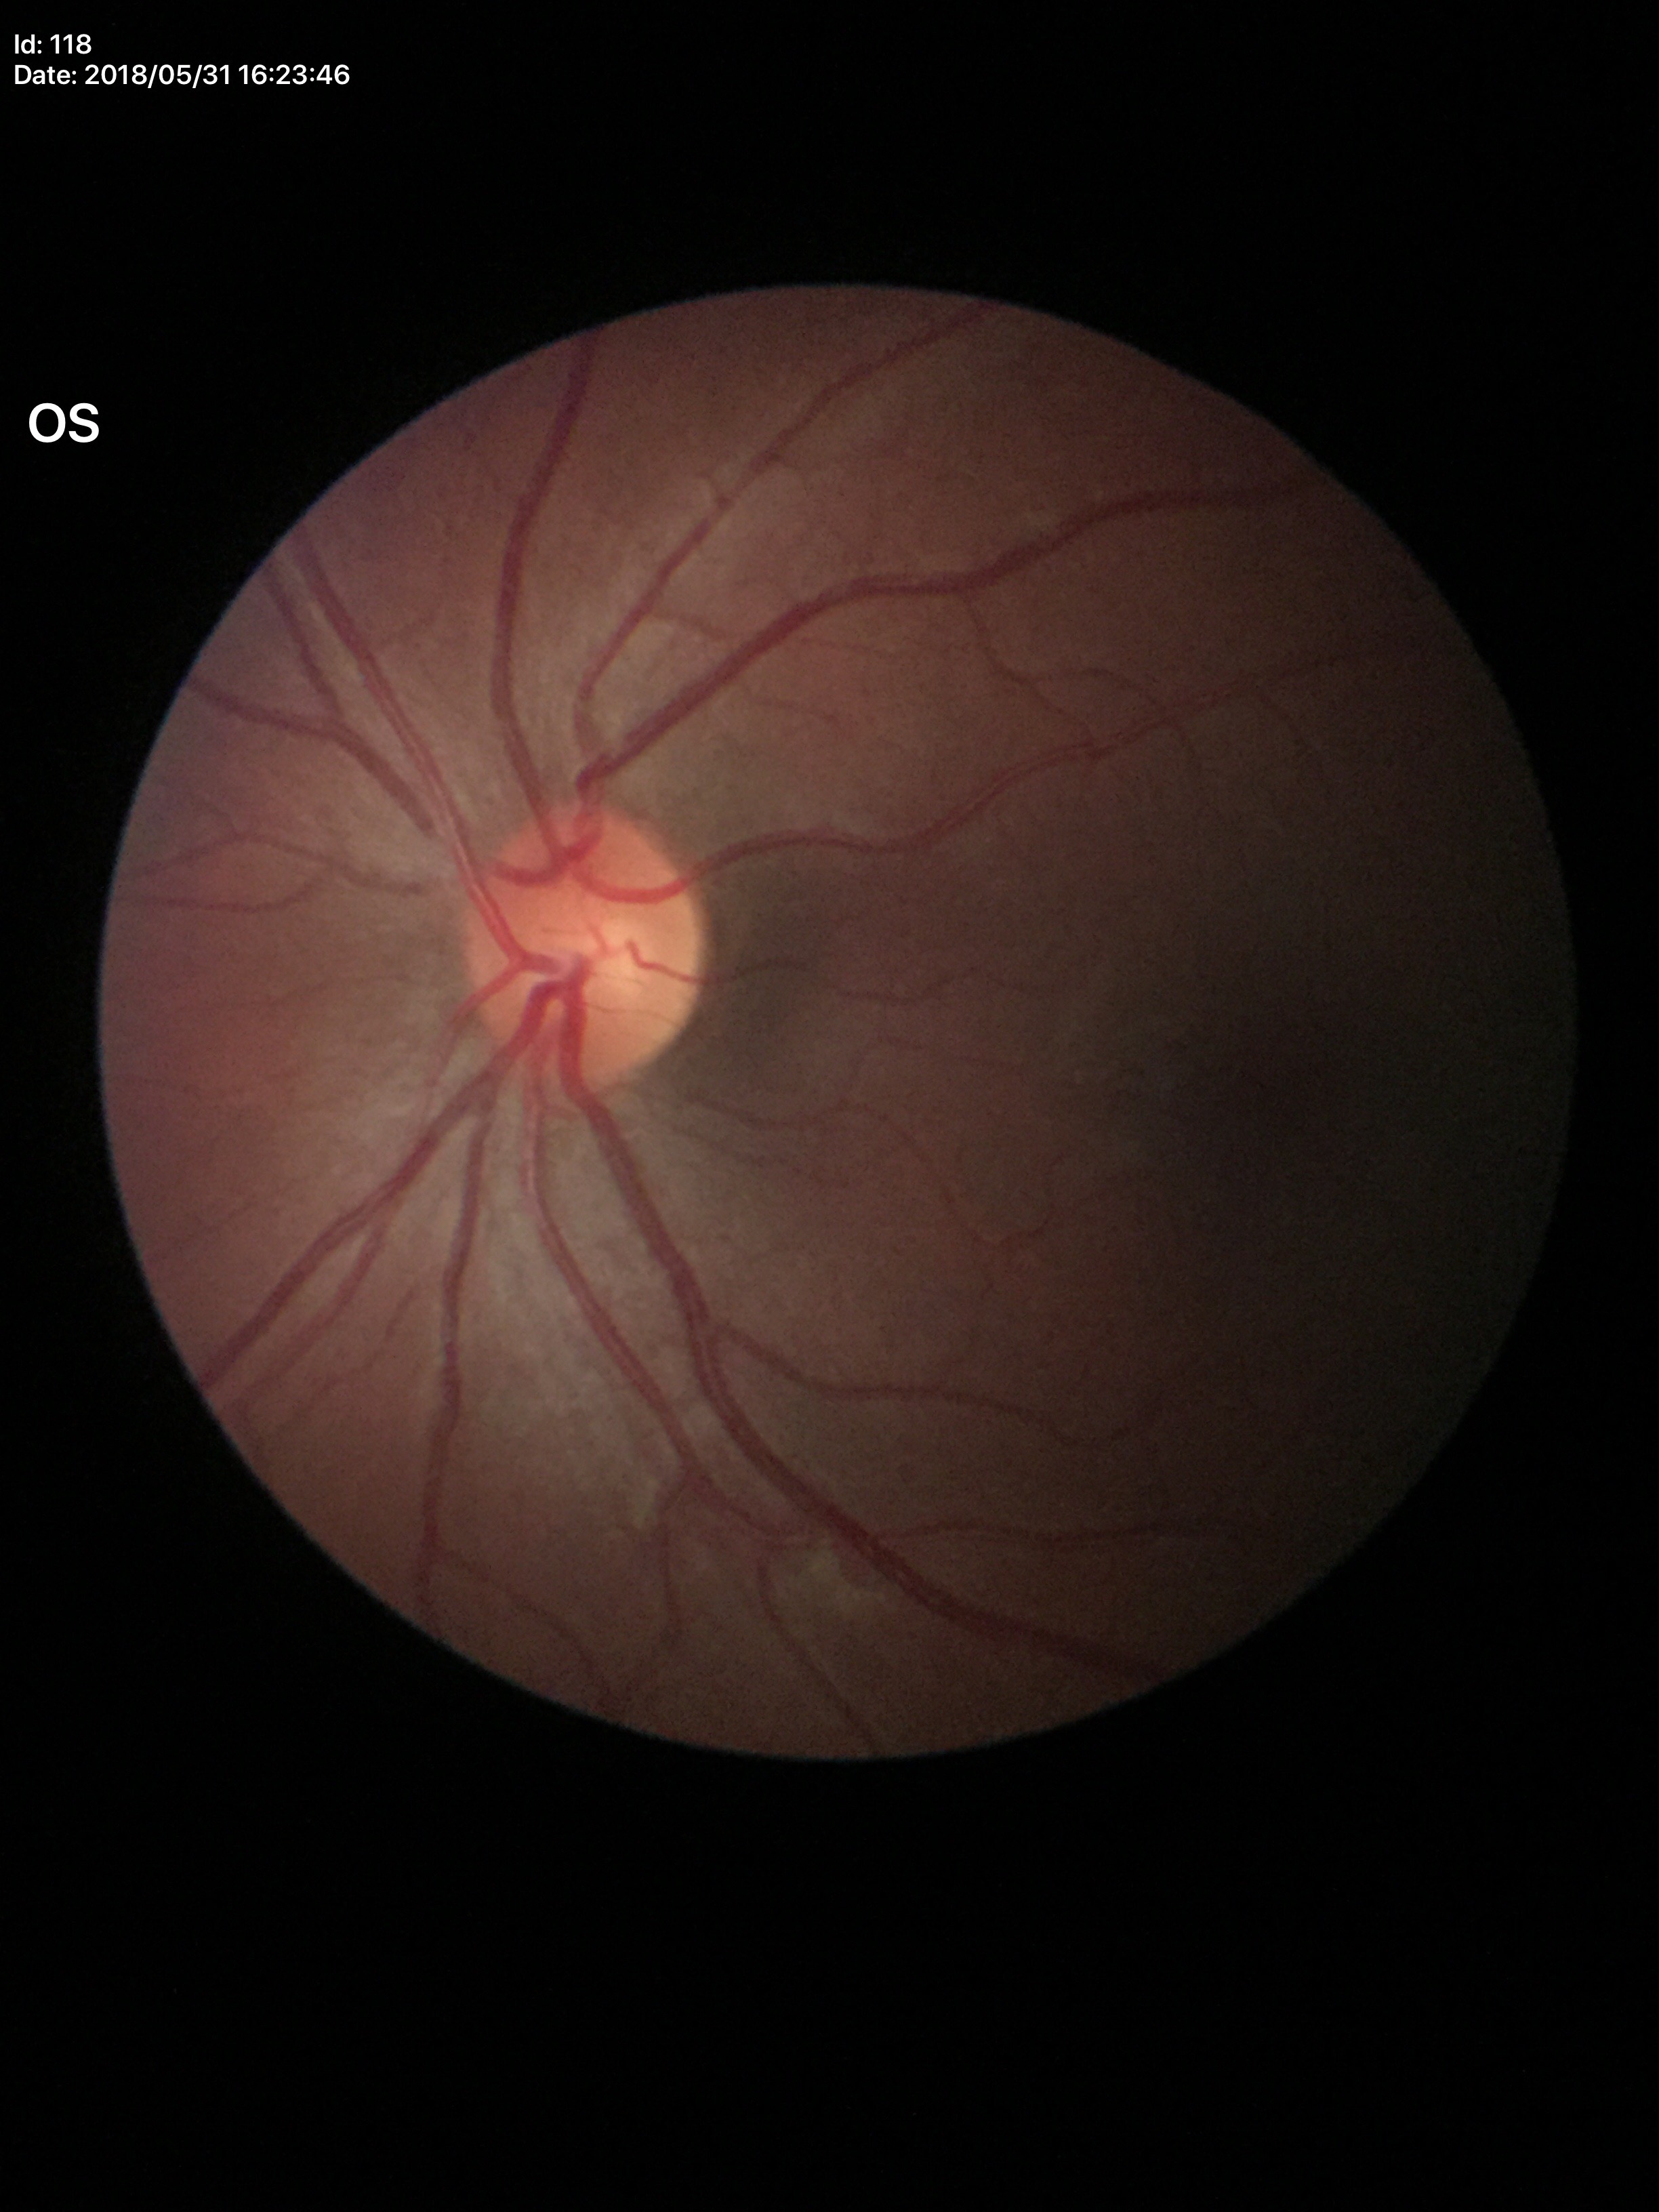

* Glaucoma screening — no suspicious findings
* vertical C/D ratio — 0.42